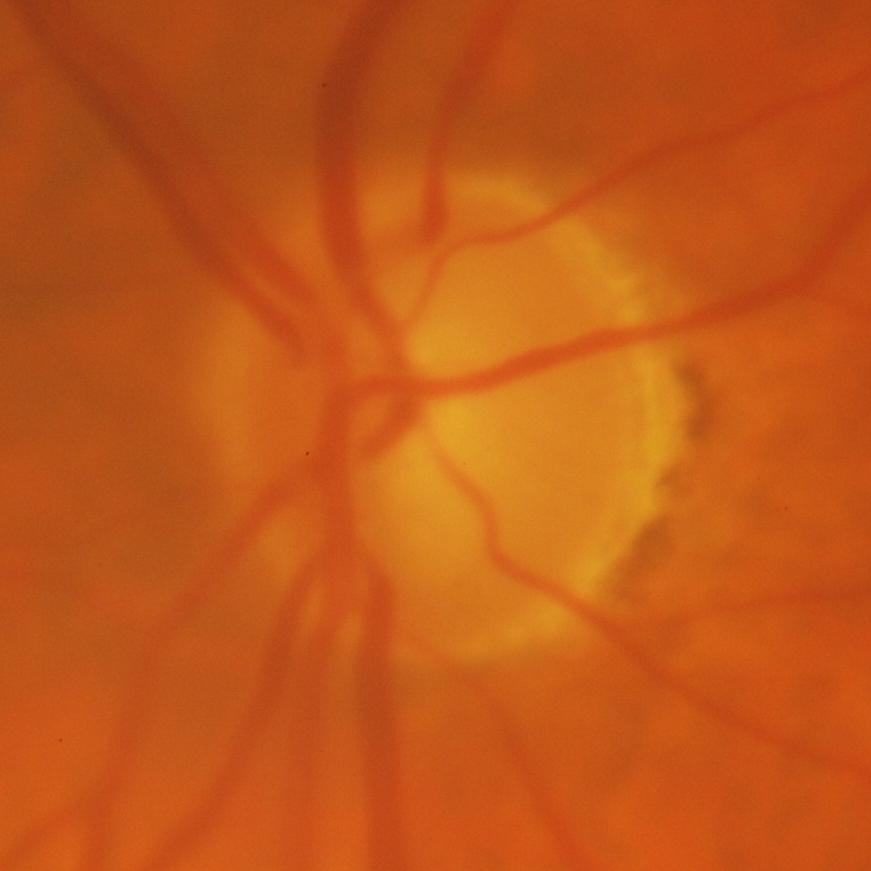 Glaucoma is present. This optic disc photograph shows glaucomatous findings.